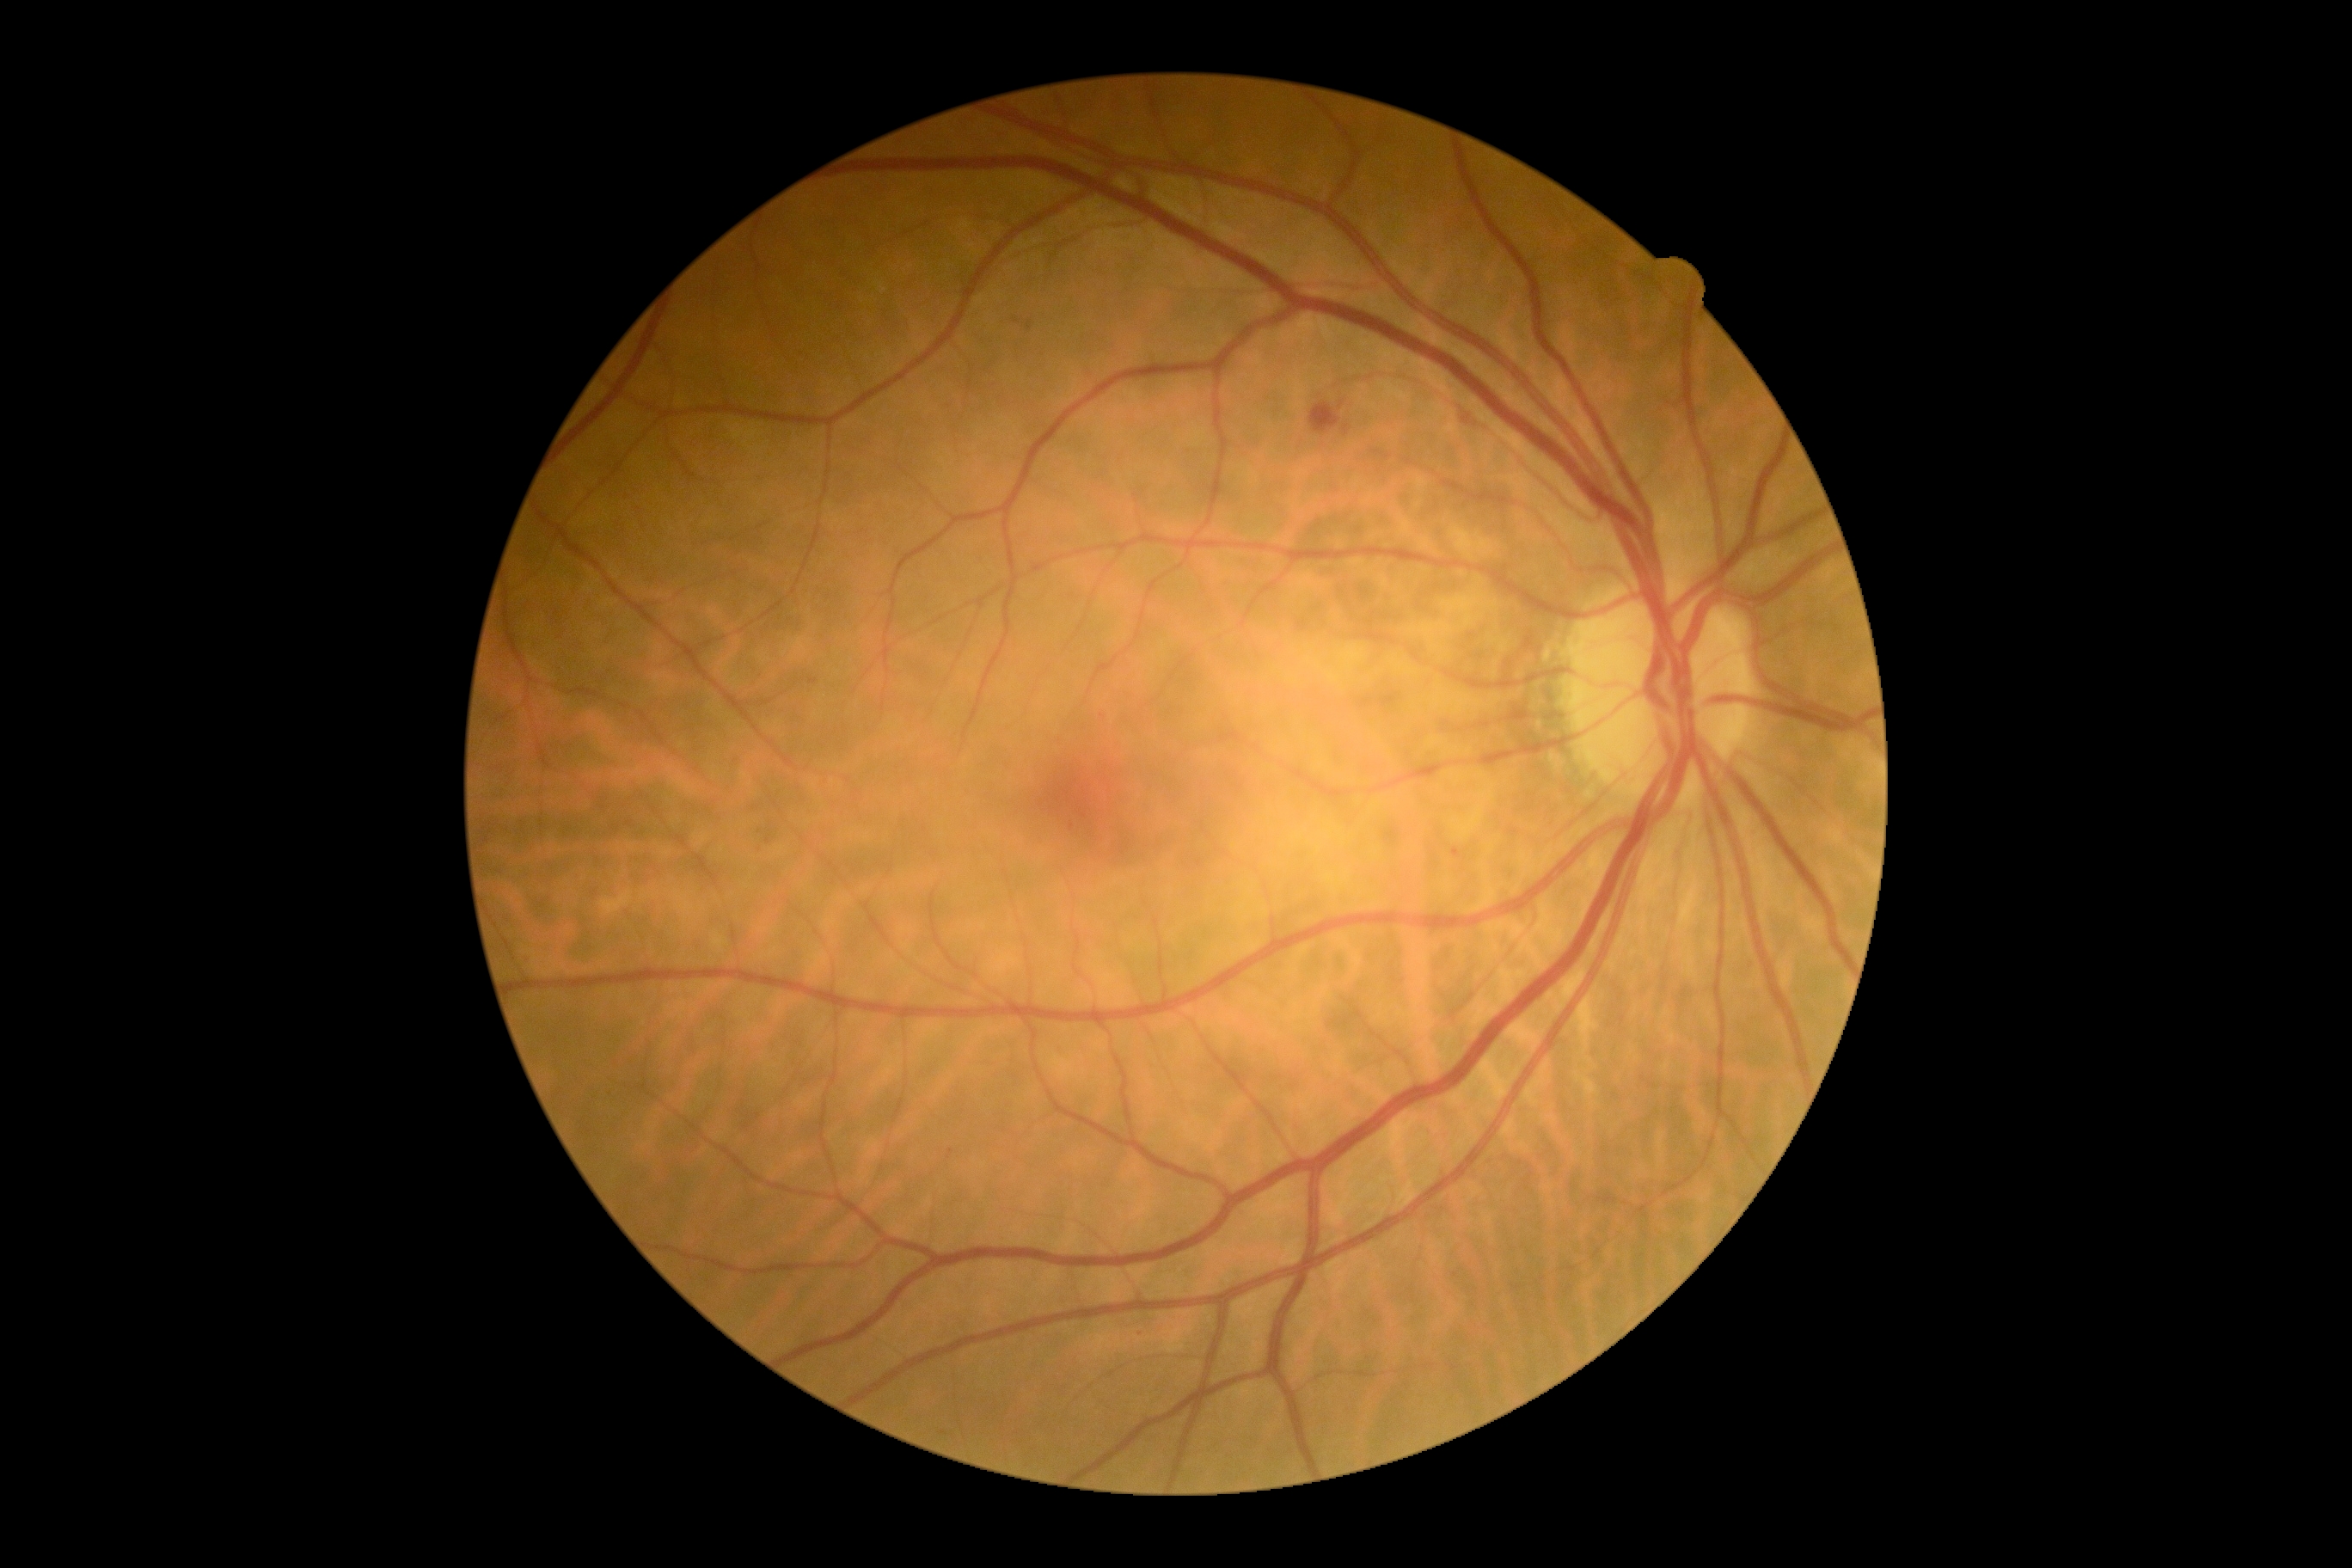
Diabetic retinopathy (DR) is moderate NPDR (grade 2) — more than just microaneurysms but less than severe NPDR.